Infant wide-field fundus photograph; image size 1440x1080:
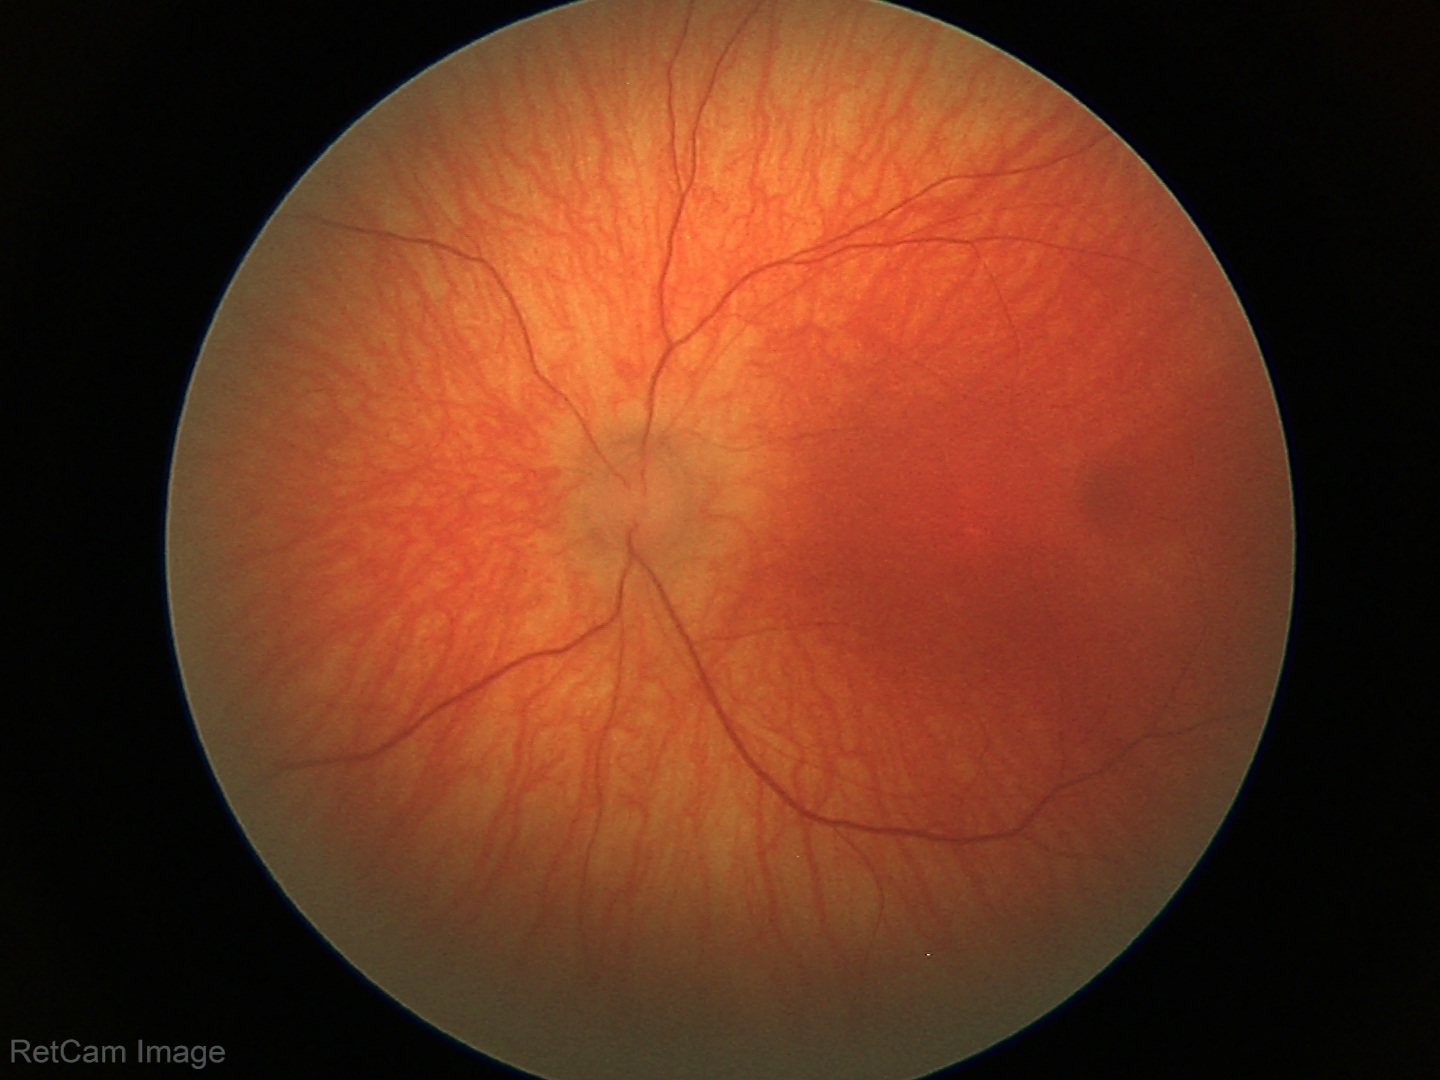

Impression = normal.